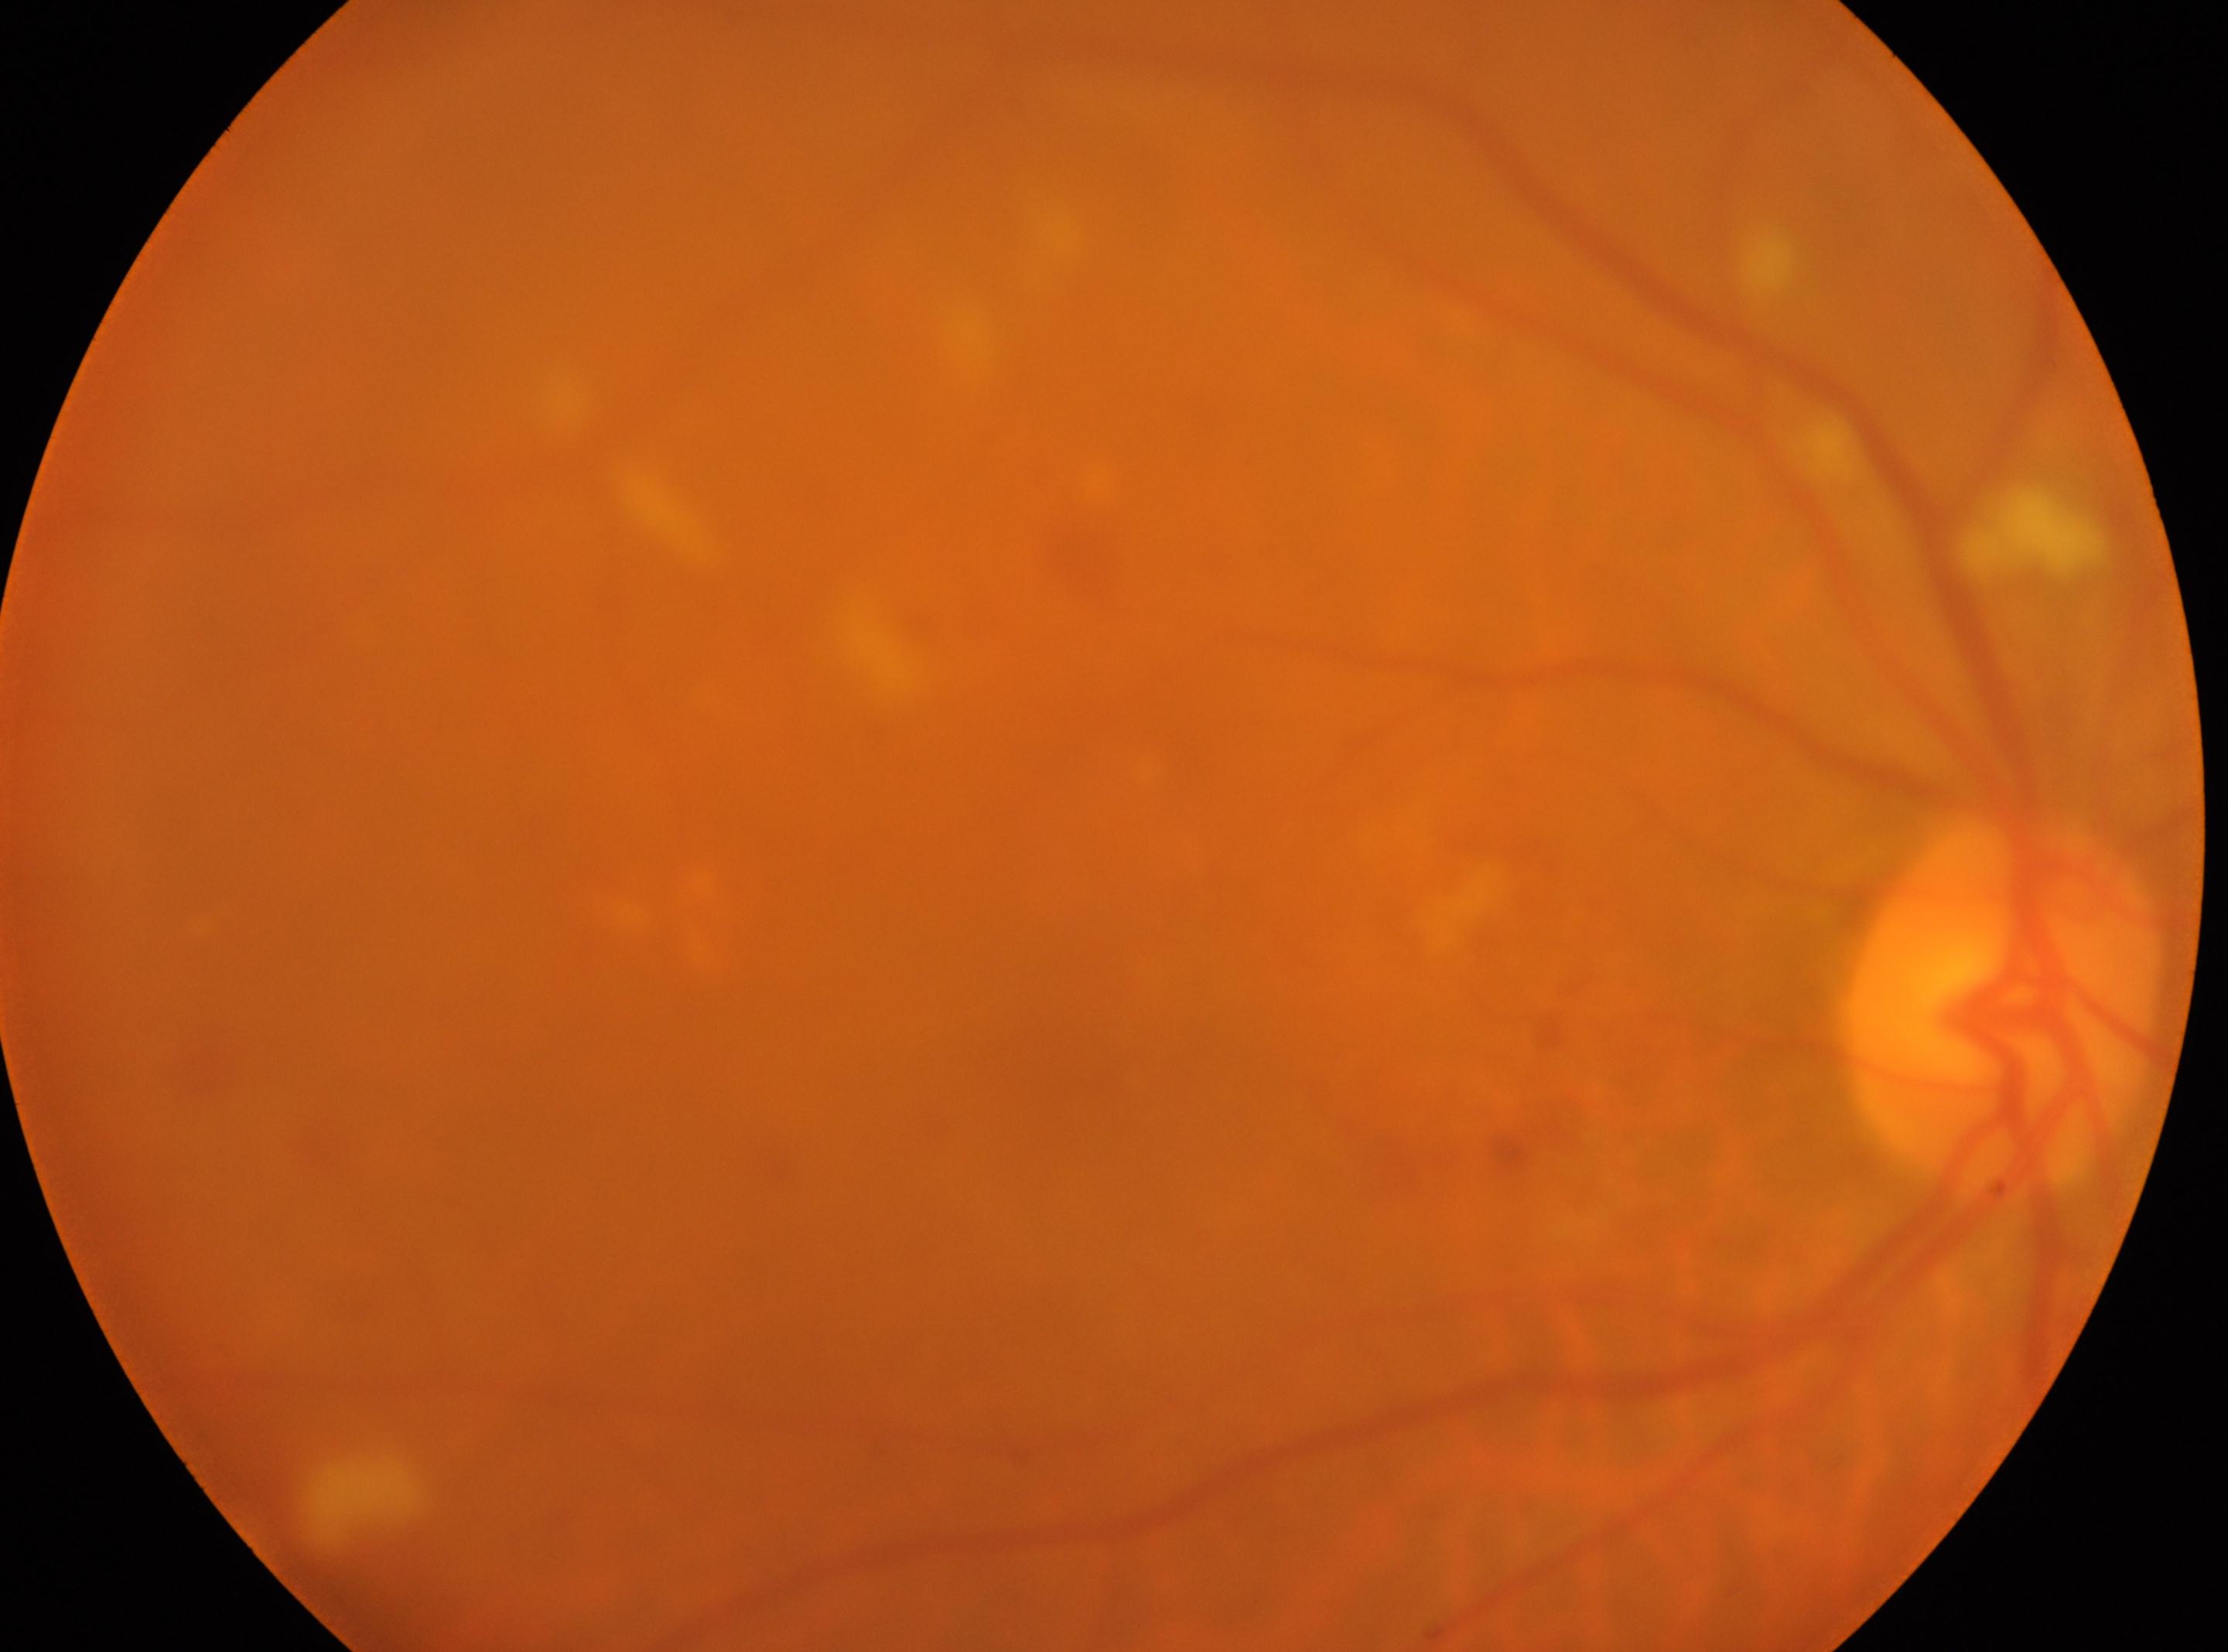 fovea: (1066,1056)
optic_disc: (2001,1004)
eye: oculus dexter
dr_grade: 2 (moderate NPDR)